Graded on the modified Davis scale: 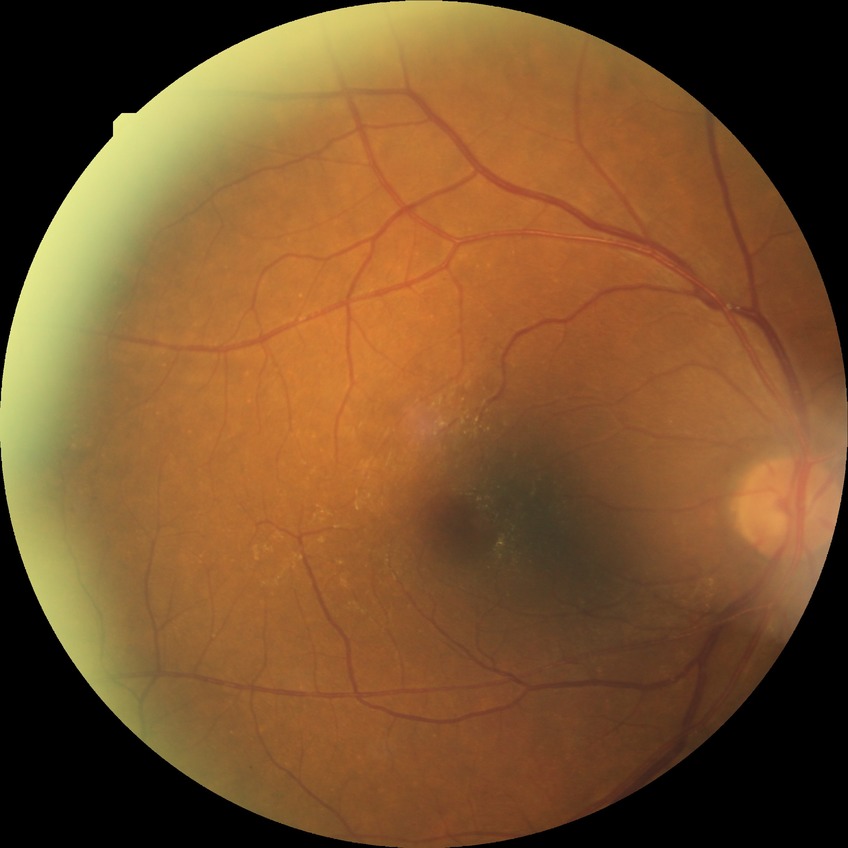

DR severity is SDR.